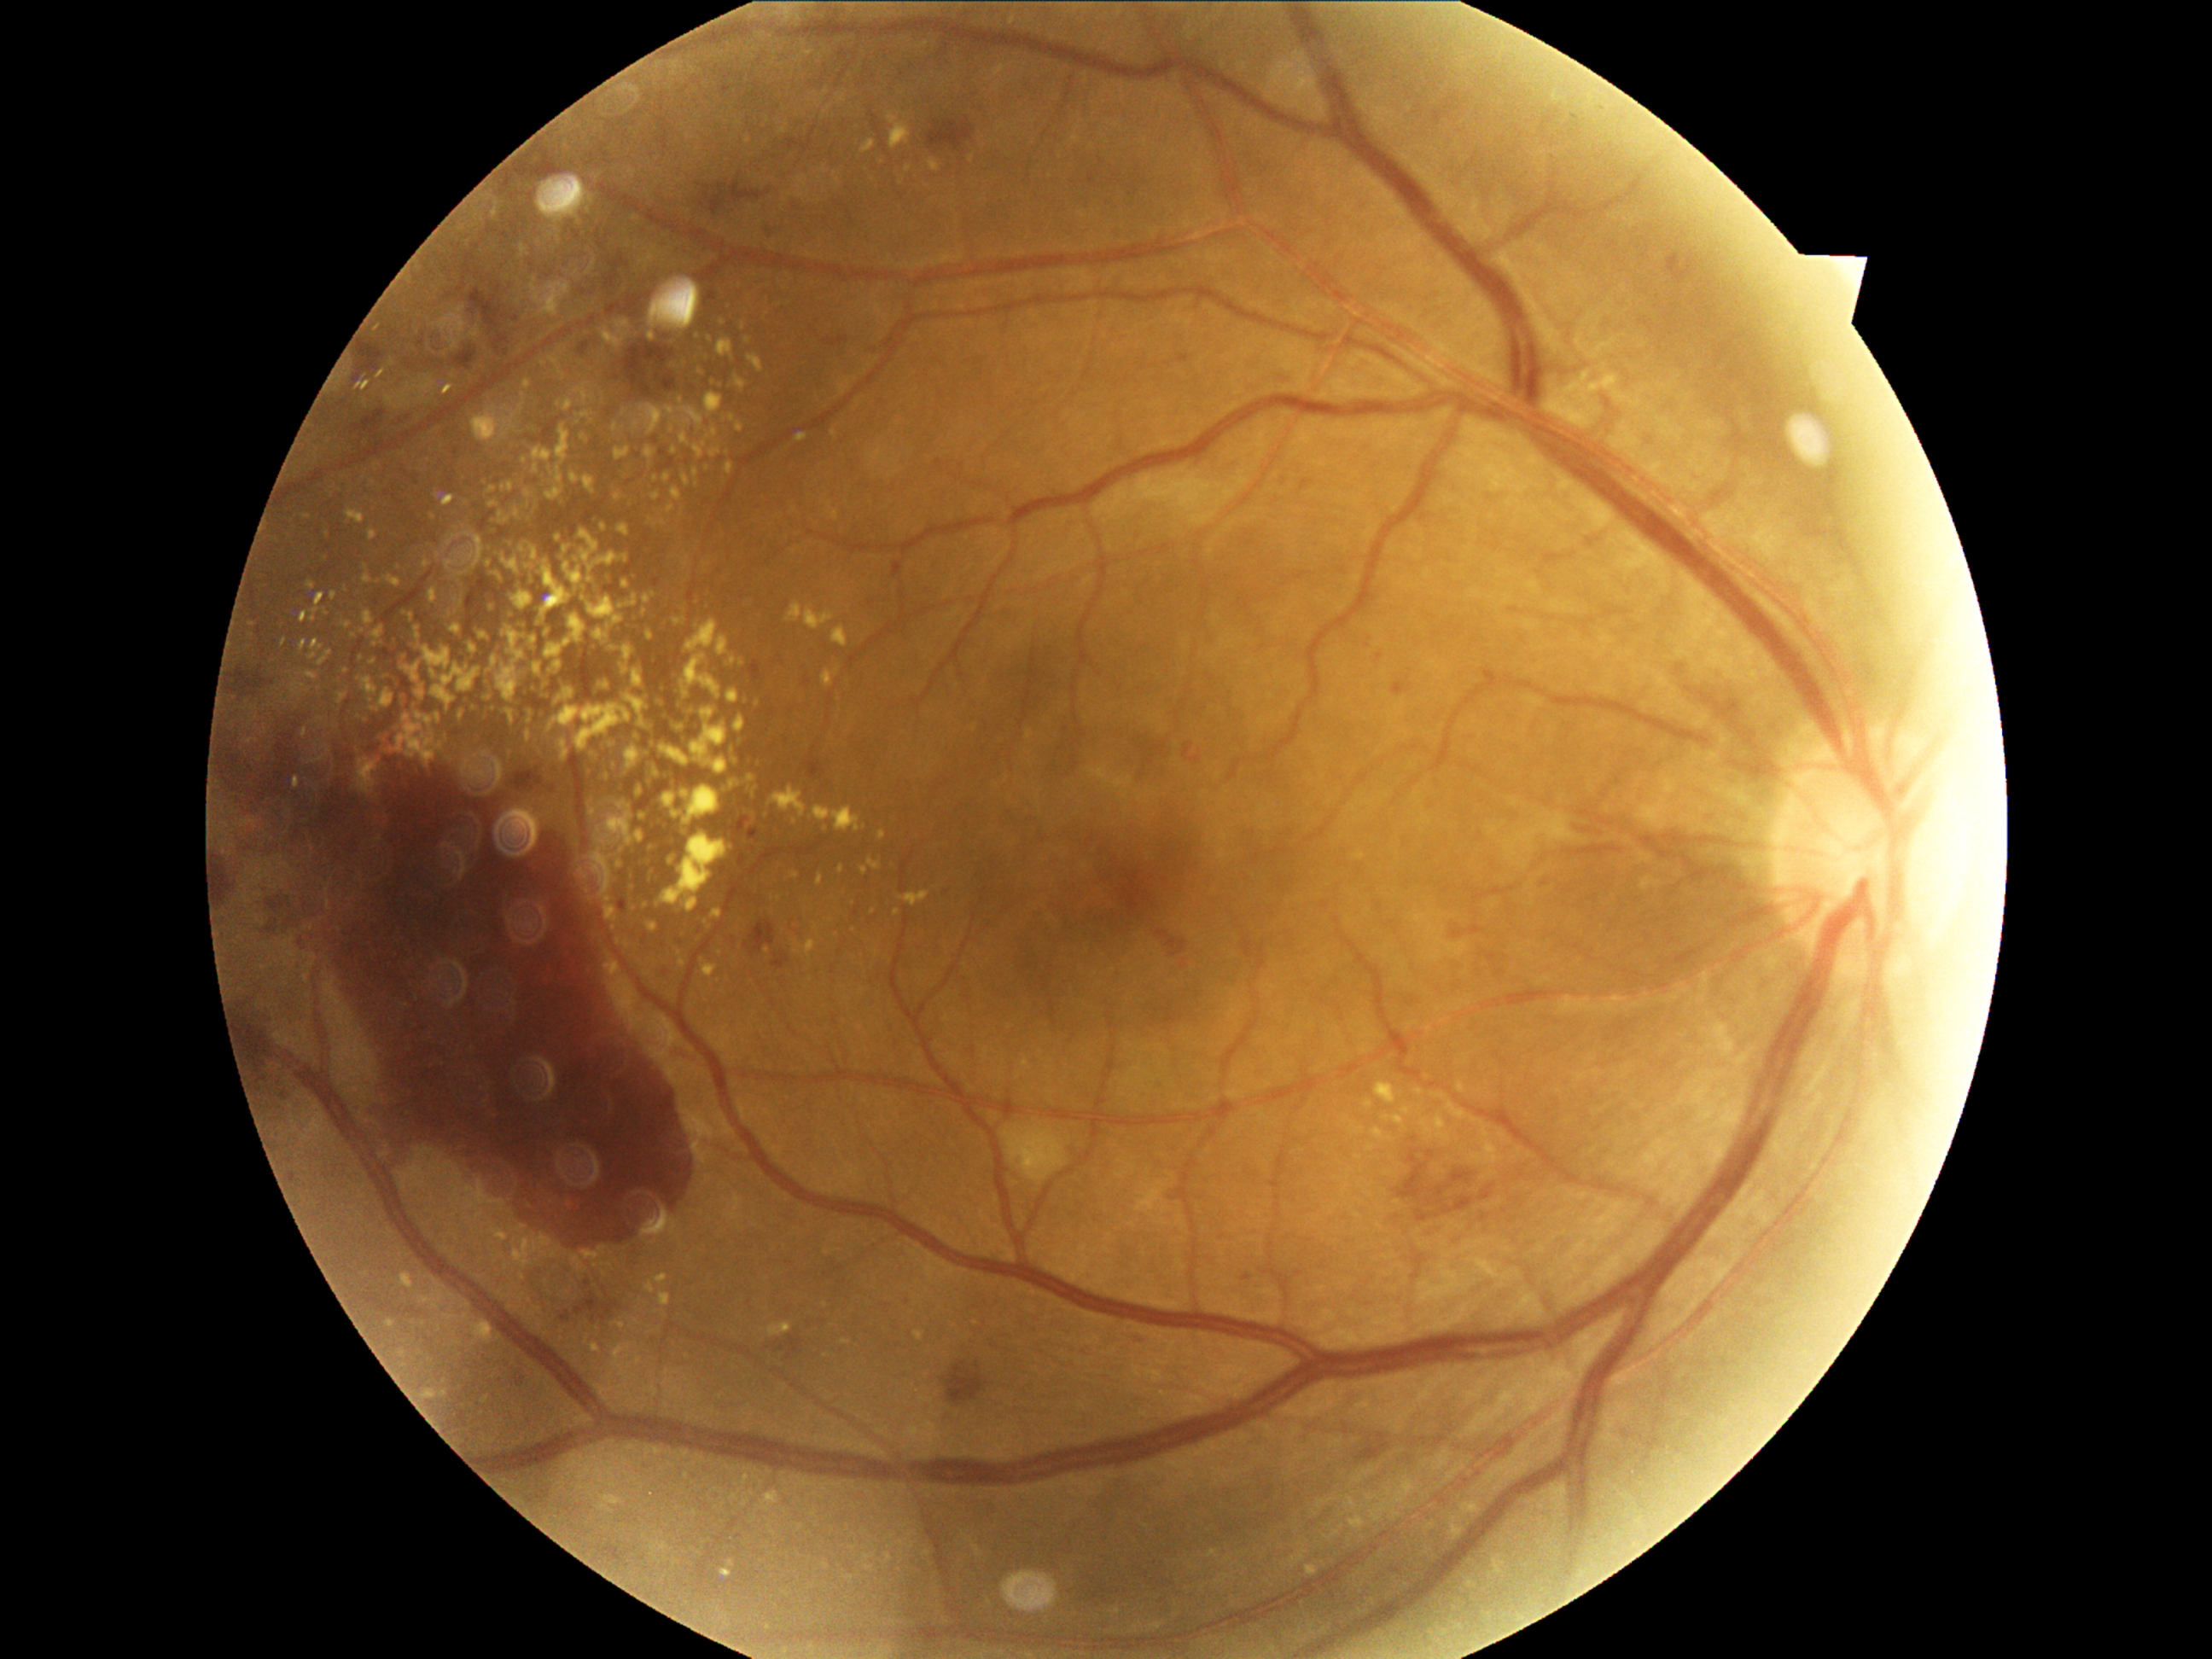 Diabetic retinopathy is grade 4 (PDR). Hard exudates include x1=593, y1=682, x2=608, y2=696, x1=595, y1=629, x2=607, y2=641, x1=644, y1=597, x2=651, y2=605, x1=849, y1=902, x2=859, y2=907, x1=501, y1=484, x2=515, y2=492, x1=590, y1=835, x2=612, y2=902, x1=728, y1=745, x2=738, y2=752, x1=694, y1=469, x2=699, y2=477, x1=646, y1=405, x2=663, y2=434, x1=685, y1=711, x2=694, y2=719, x1=581, y1=1249, x2=605, y2=1260, x1=554, y1=661, x2=564, y2=670. Additional small hard exudates near (719,323), (685,741), (529,495), (626,558), (577,560), (773,897), (680,686).